2346 by 1568 pixels: 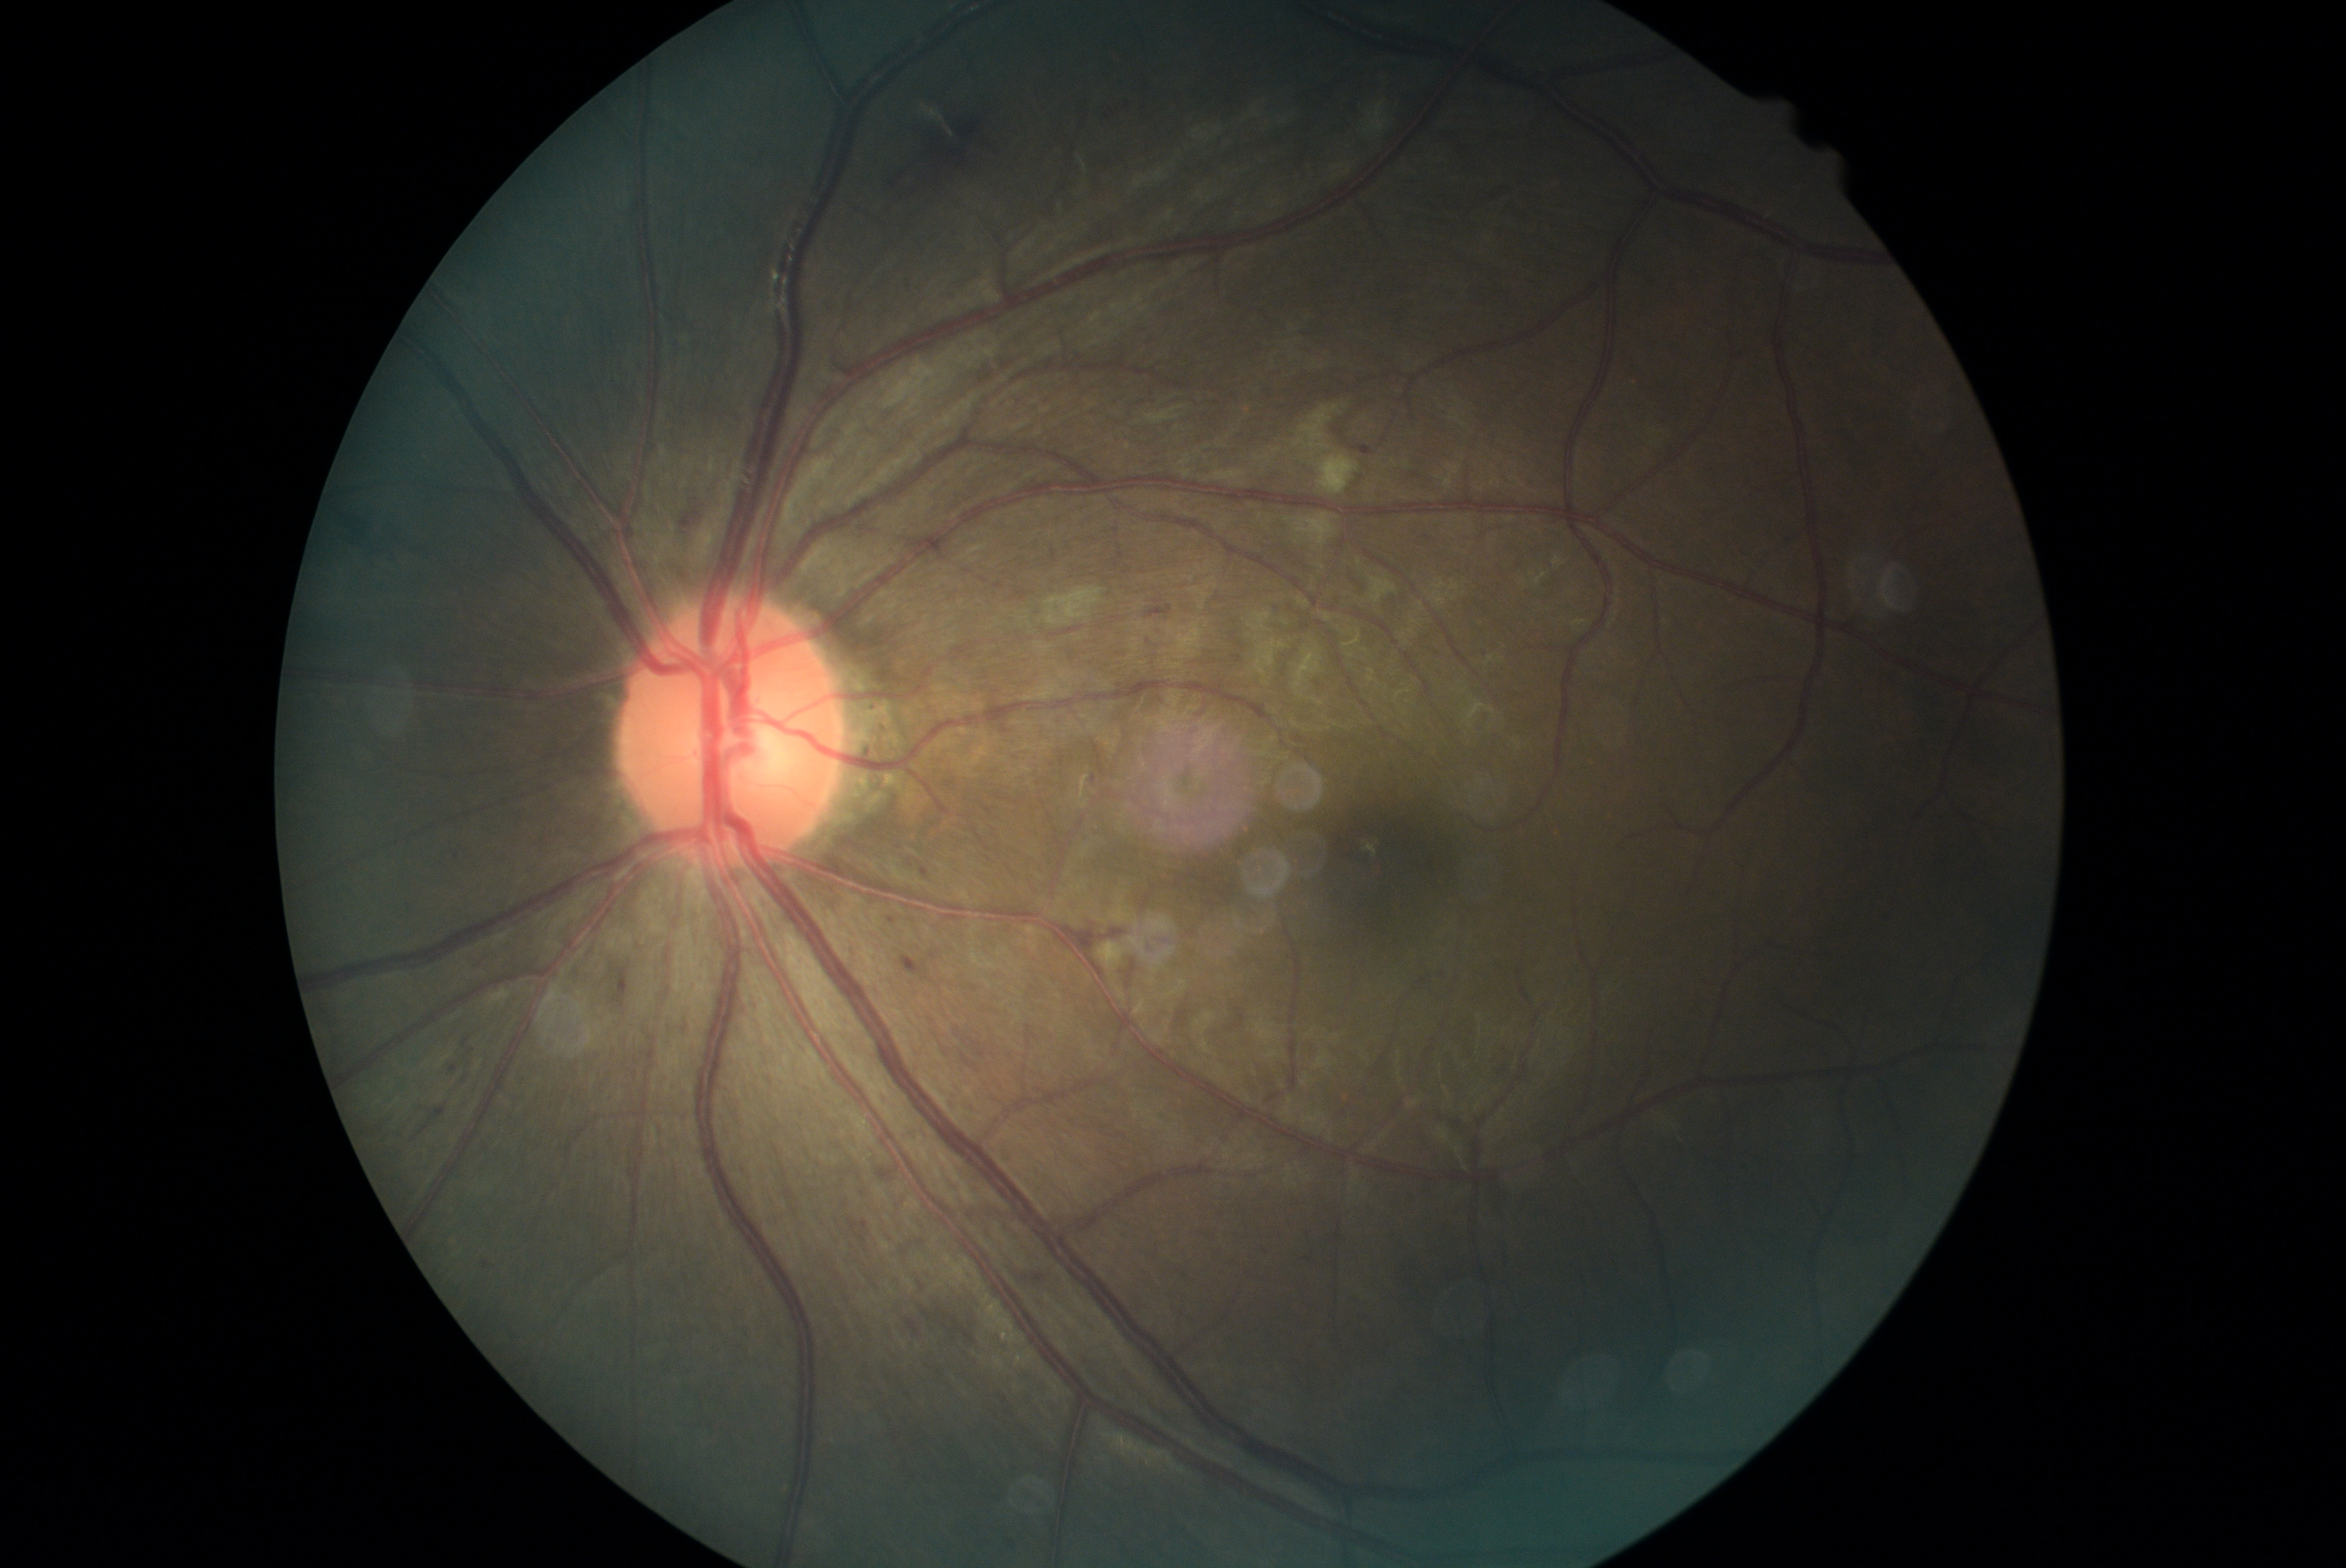
Annotations:
* DR class: non-proliferative diabetic retinopathy
* DR stage: 2